45° FOV · NIDEK AFC-230 fundus camera · nonmydriatic fundus photograph · image size 848x848:
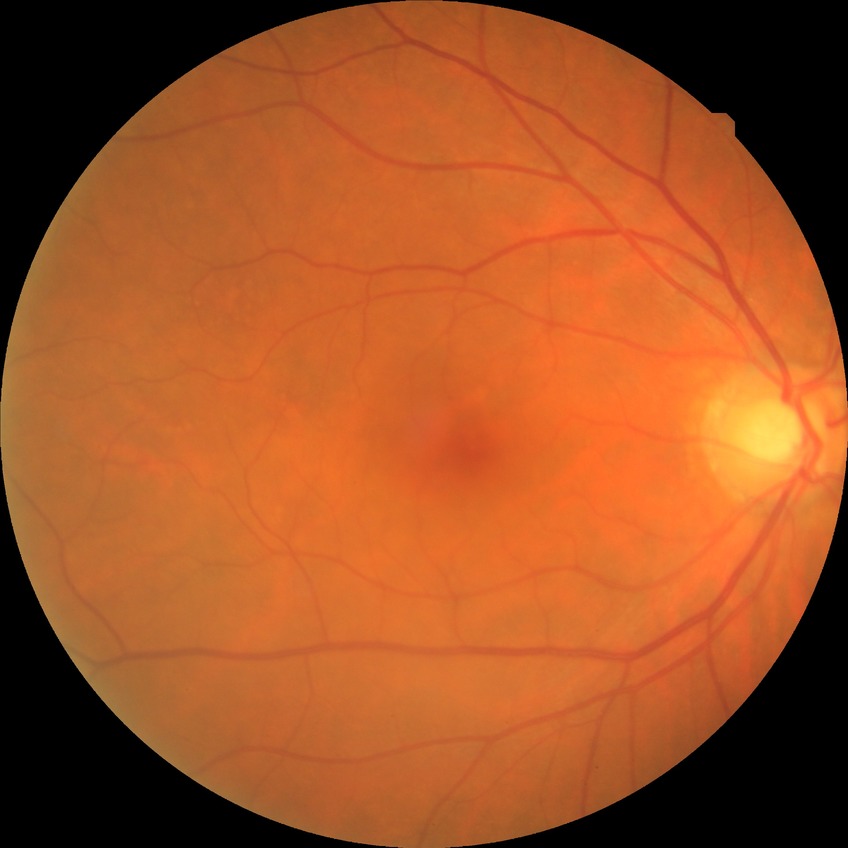
Retinopathy grade: no diabetic retinopathy.